848x848px. Acquired with a NIDEK AFC-230
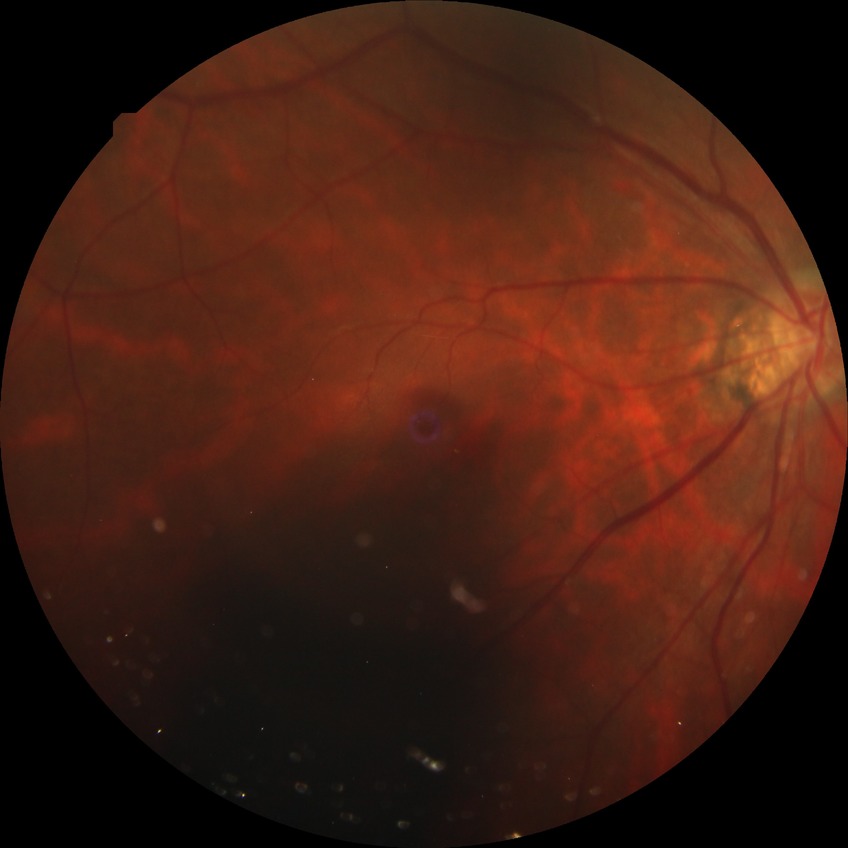

Davis stage is NDR.